Image size 640x480. Wide-field fundus photograph of an infant
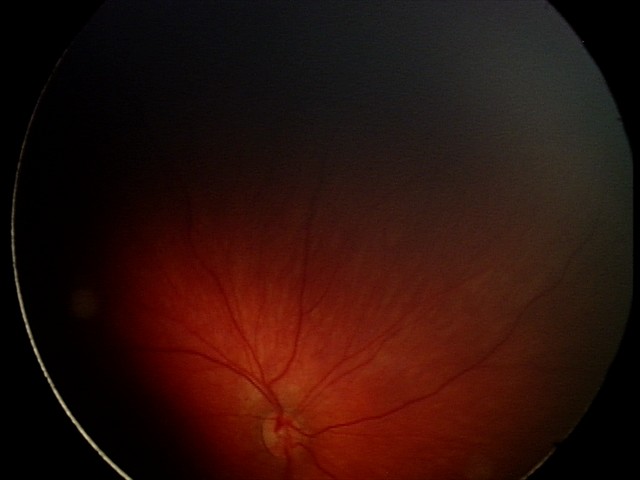 Series diagnosed as retinal hemorrhages.